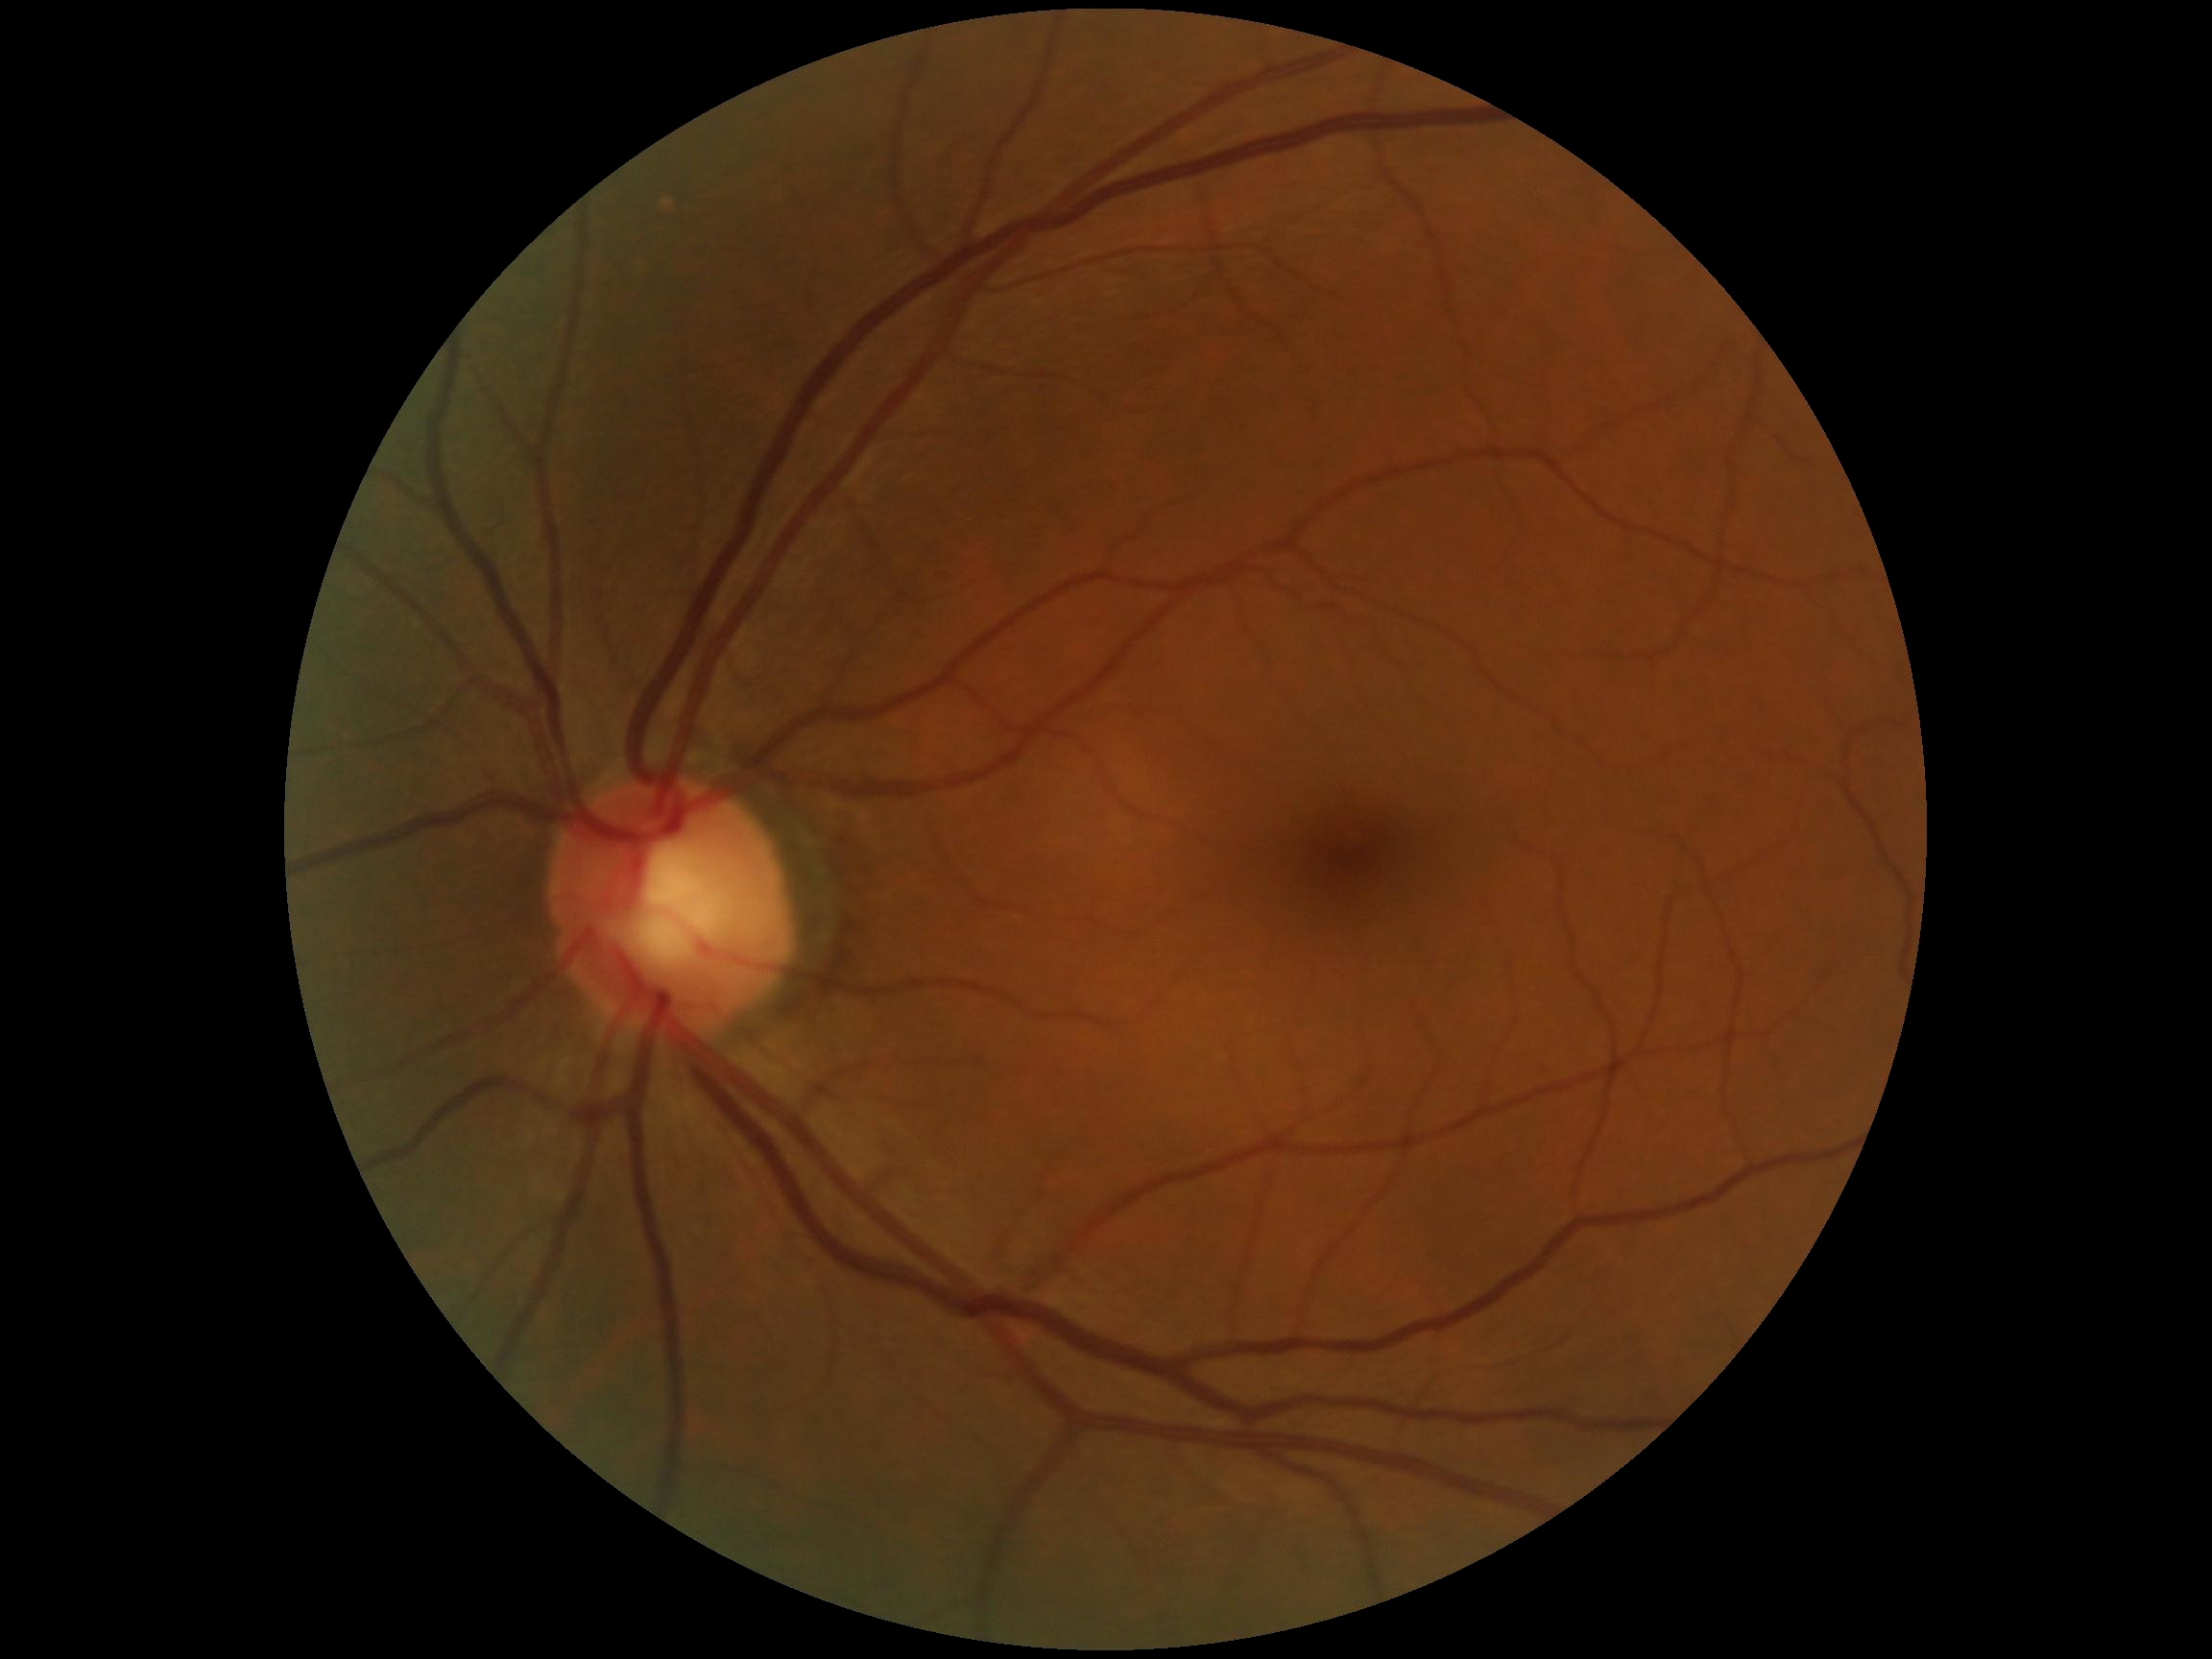 Diabetic retinopathy (DR): 0.